Wide-field fundus photograph from neonatal ROP screening. Phoenix ICON, 100° FOV: 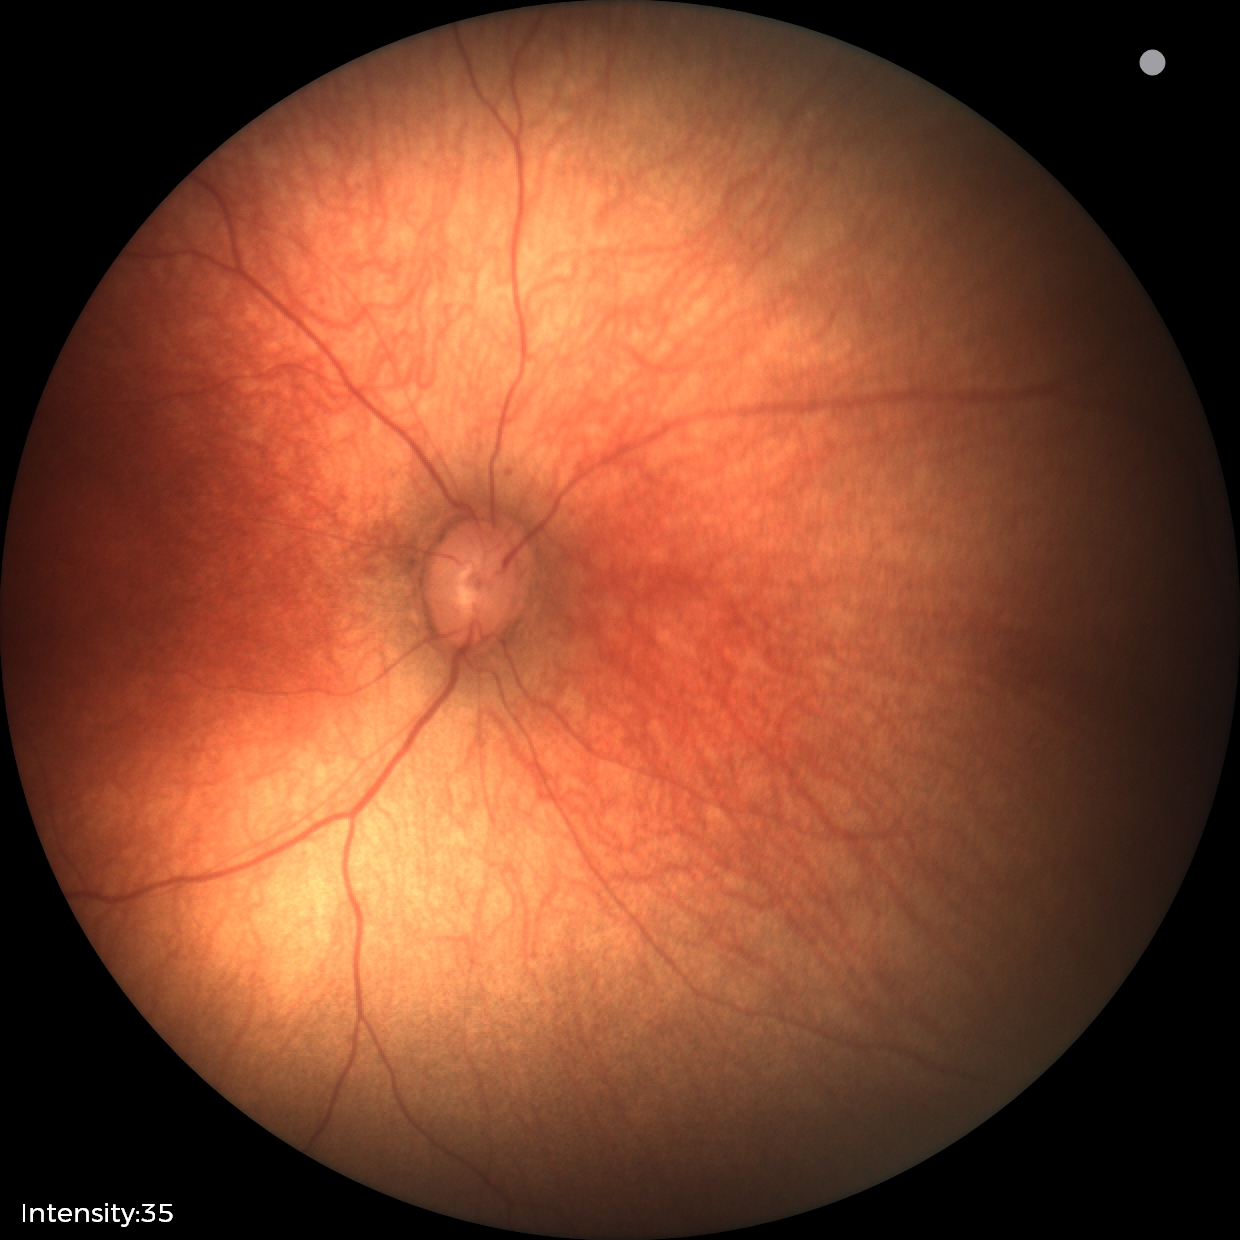
Normal screening examination.